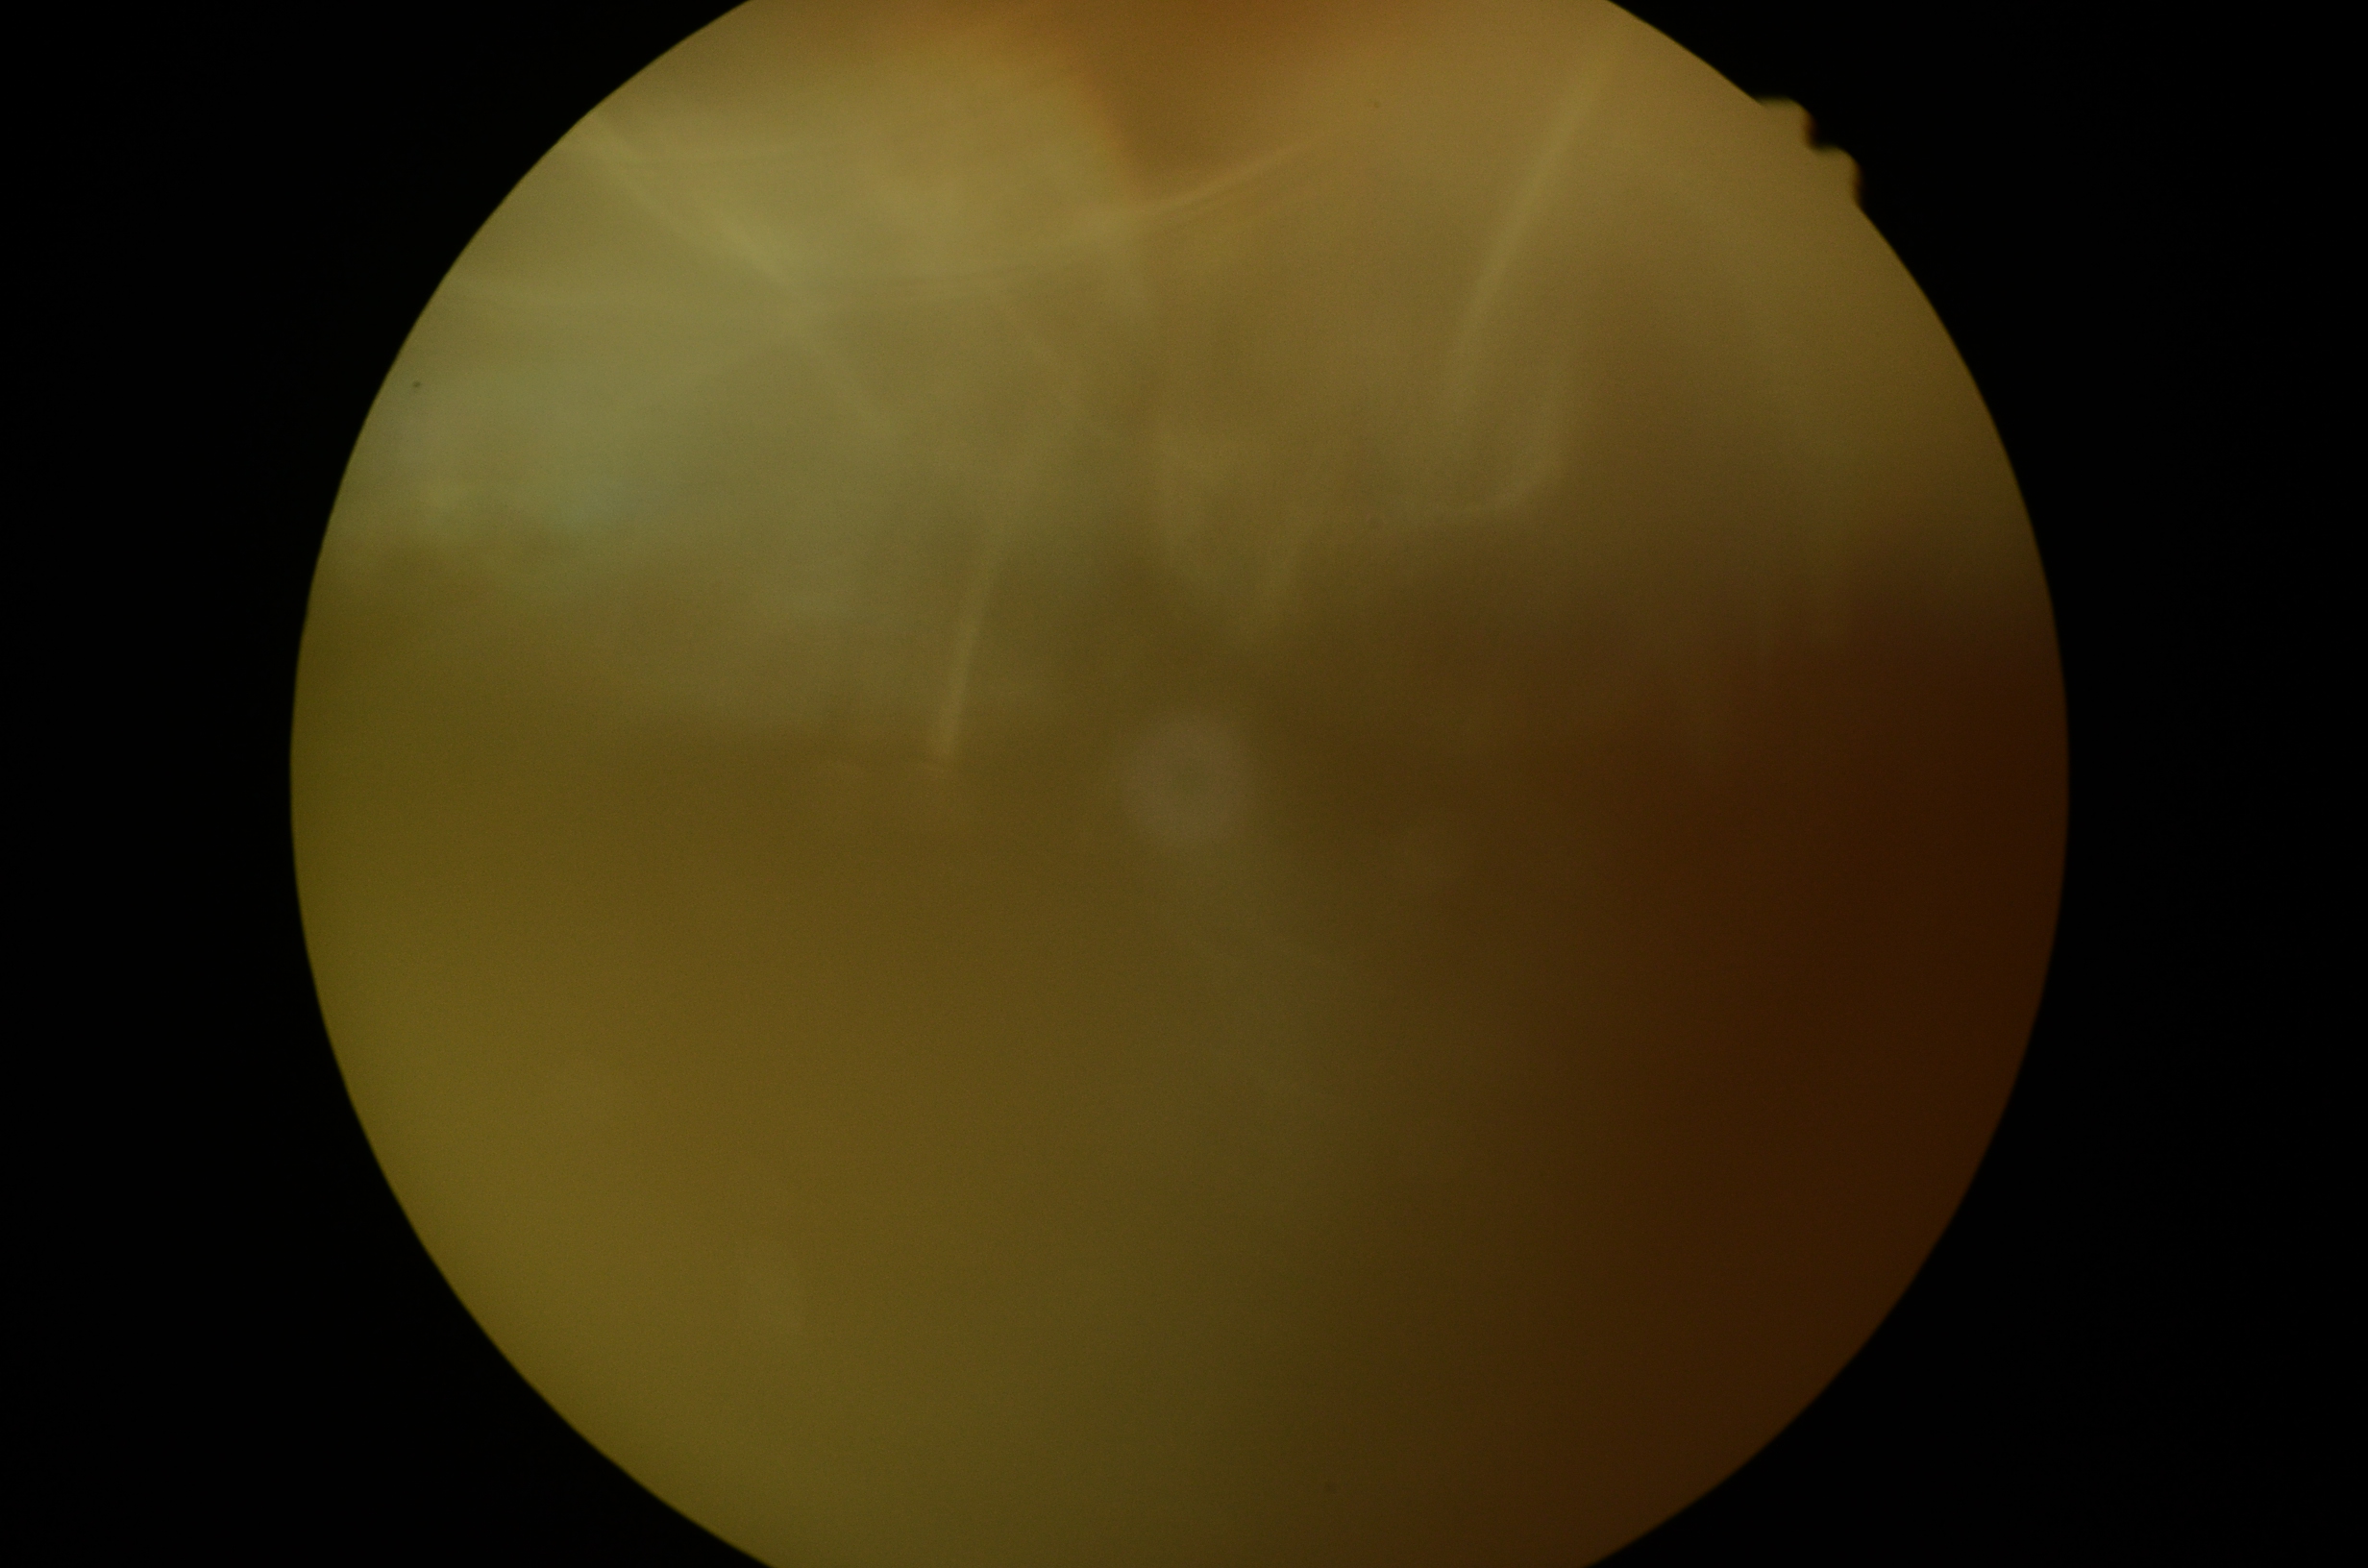
DR: ungradable due to poor image quality.